FOV: 45 degrees:
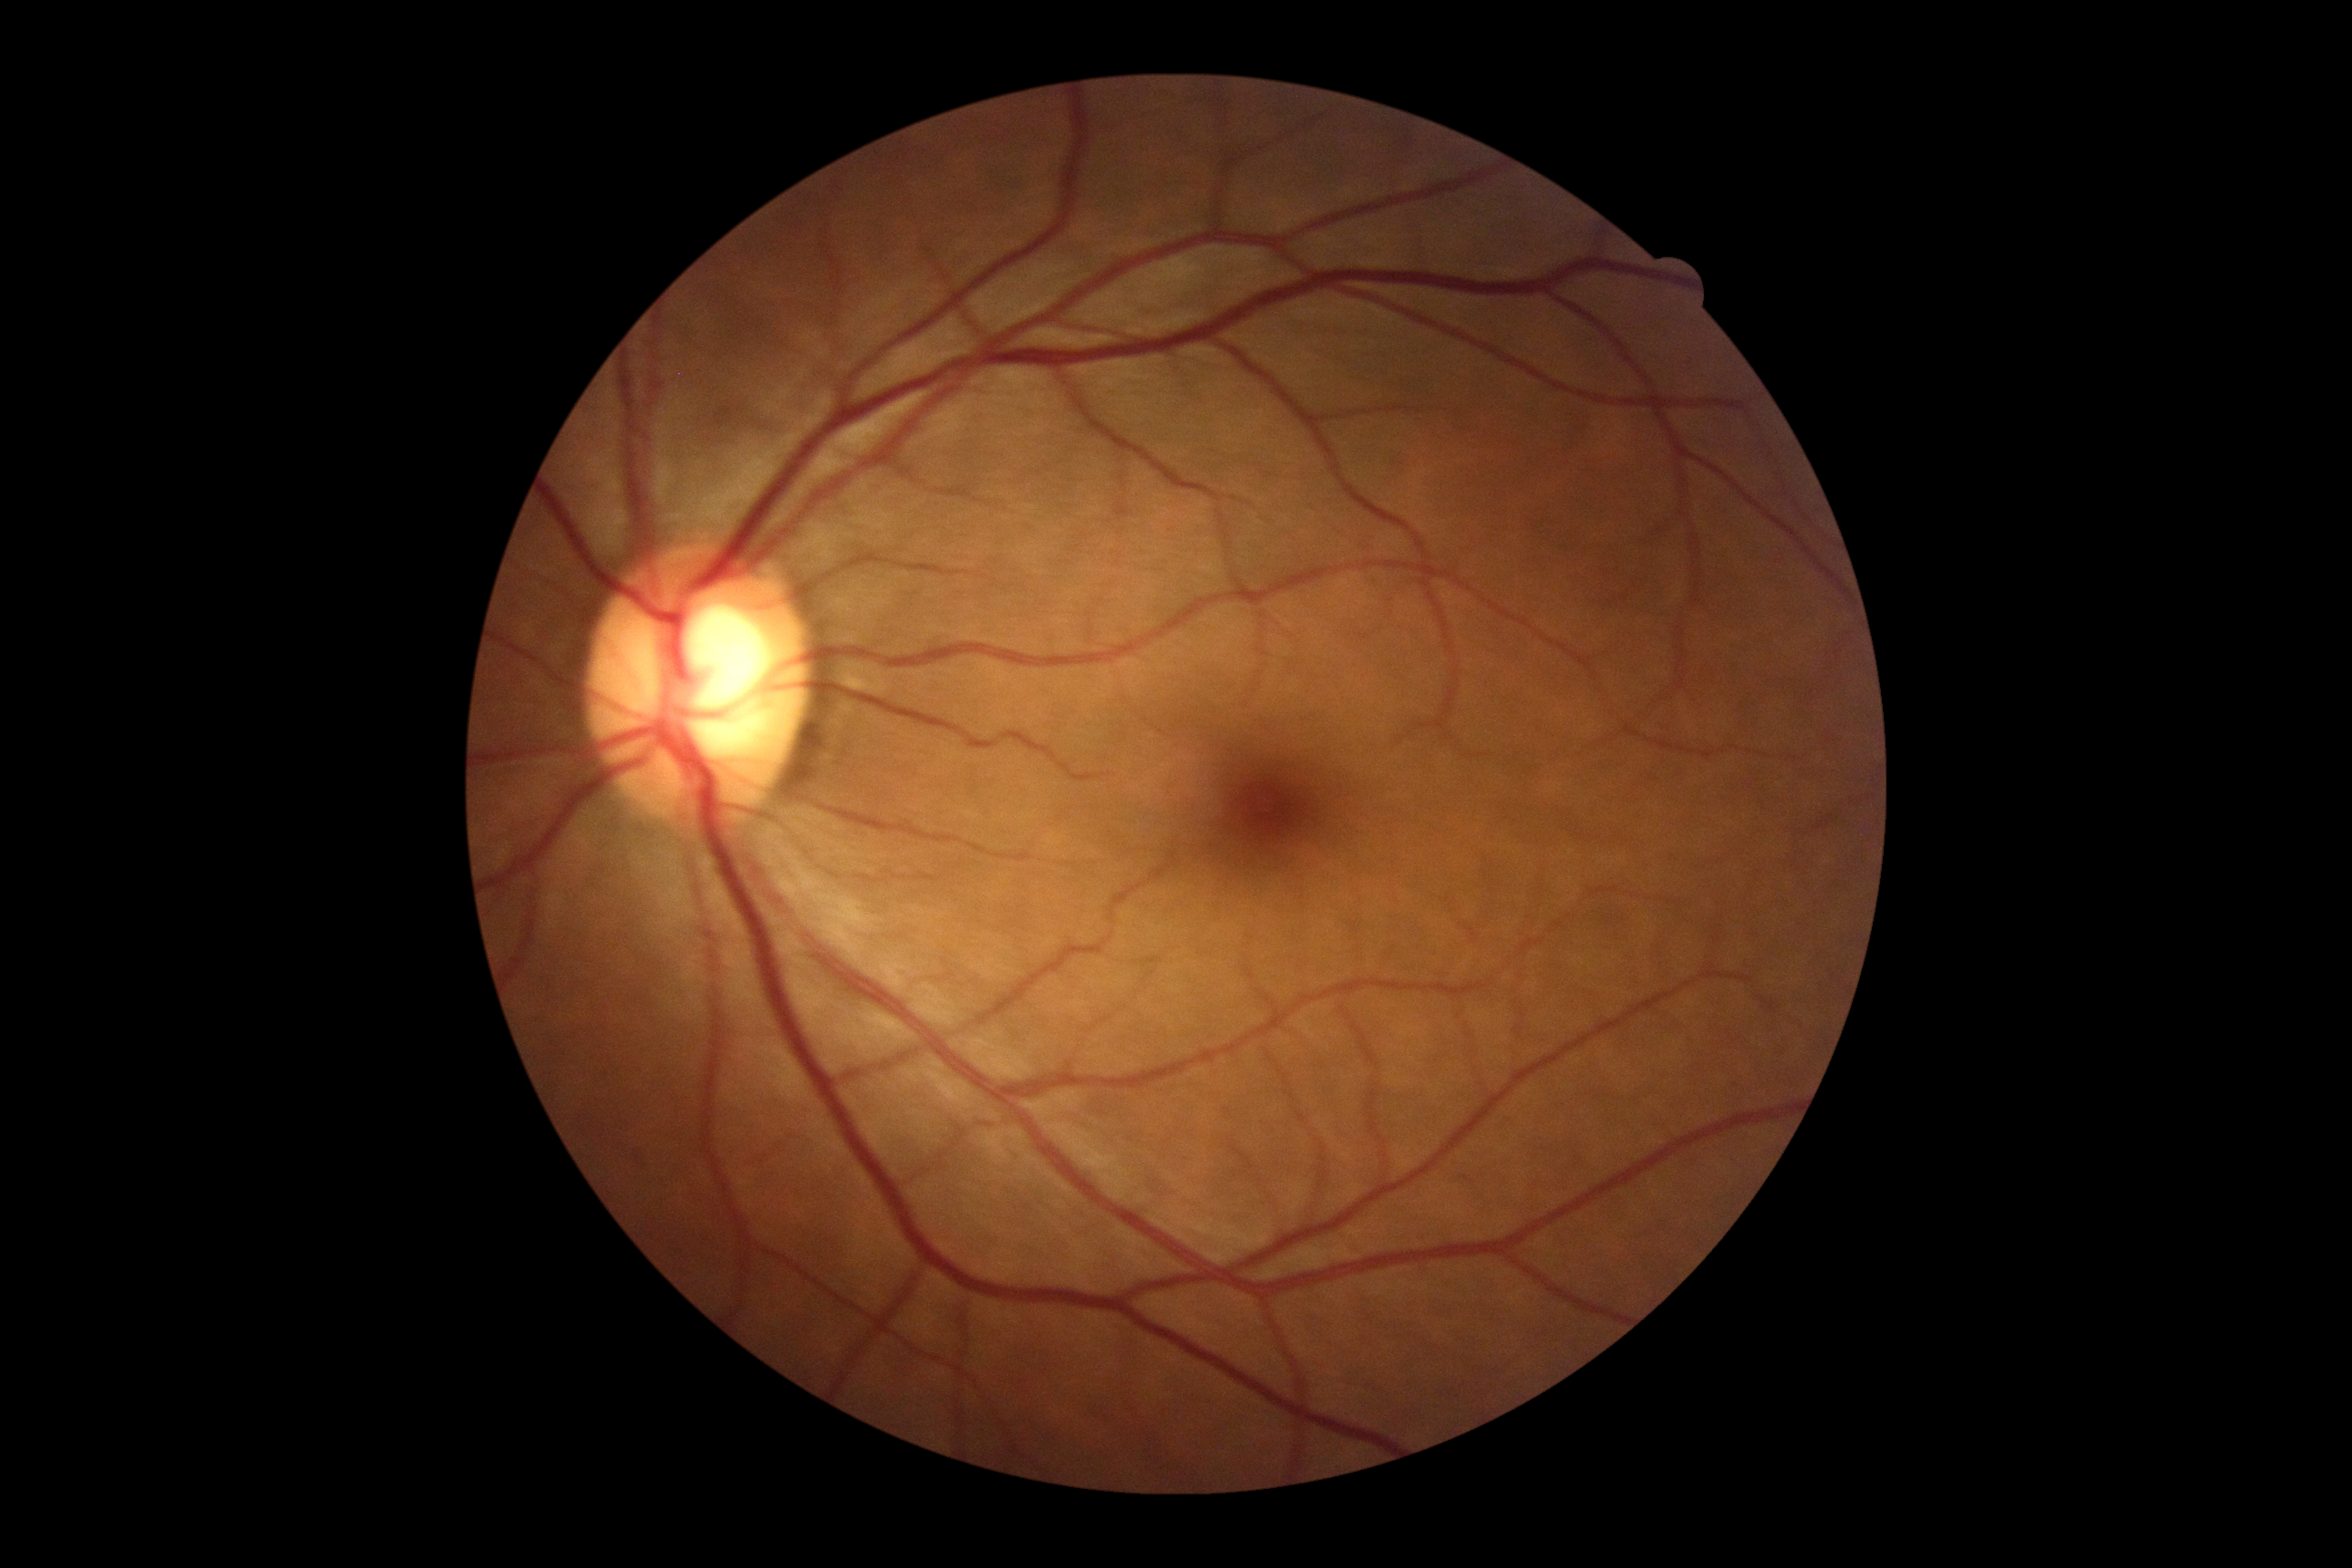 DR severity: grade 0 (no apparent retinopathy).